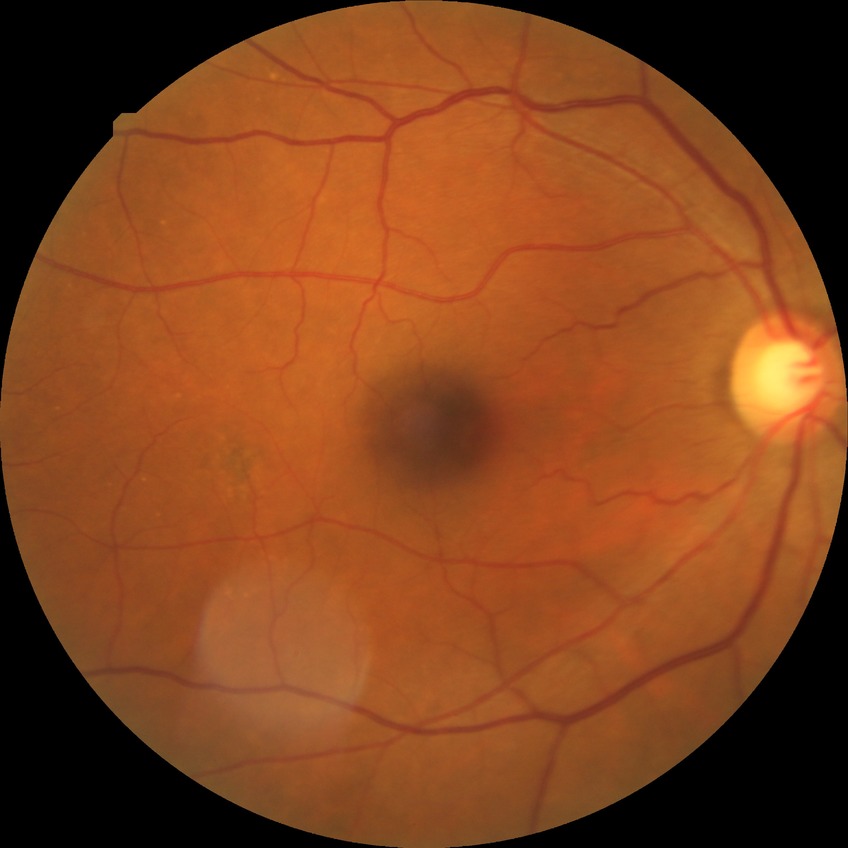 Davis stage: NDR.